NIDEK AFC-230 fundus camera · image size 848x848 · CFP · no pharmacologic dilation.
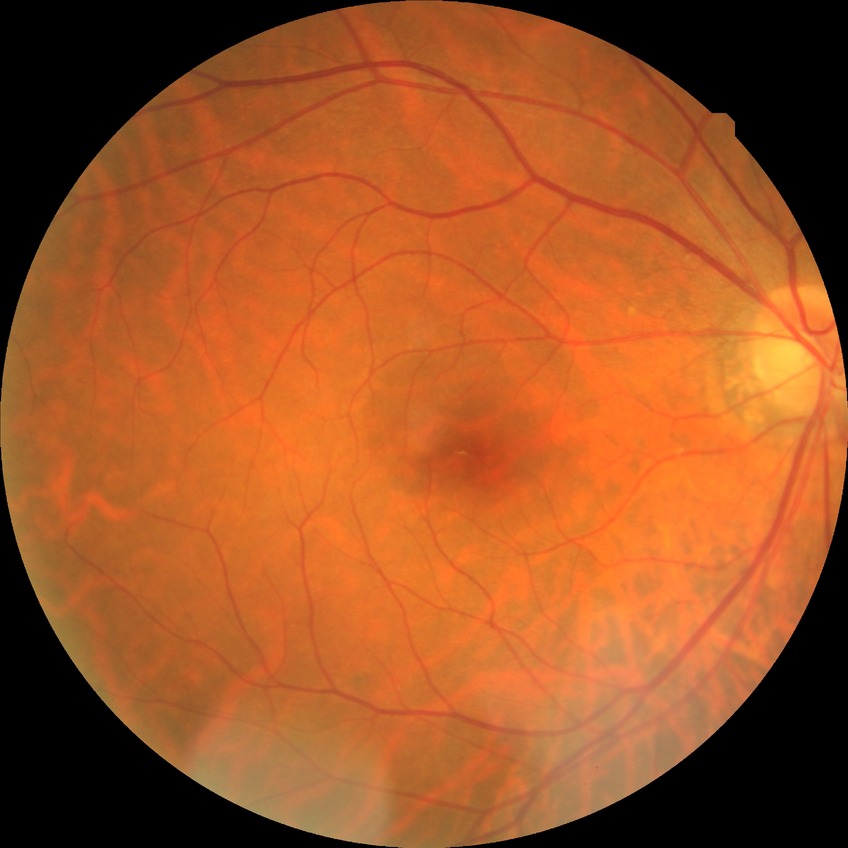 – Davis grade — NDR